45° FOV, 848 x 848 pixels.
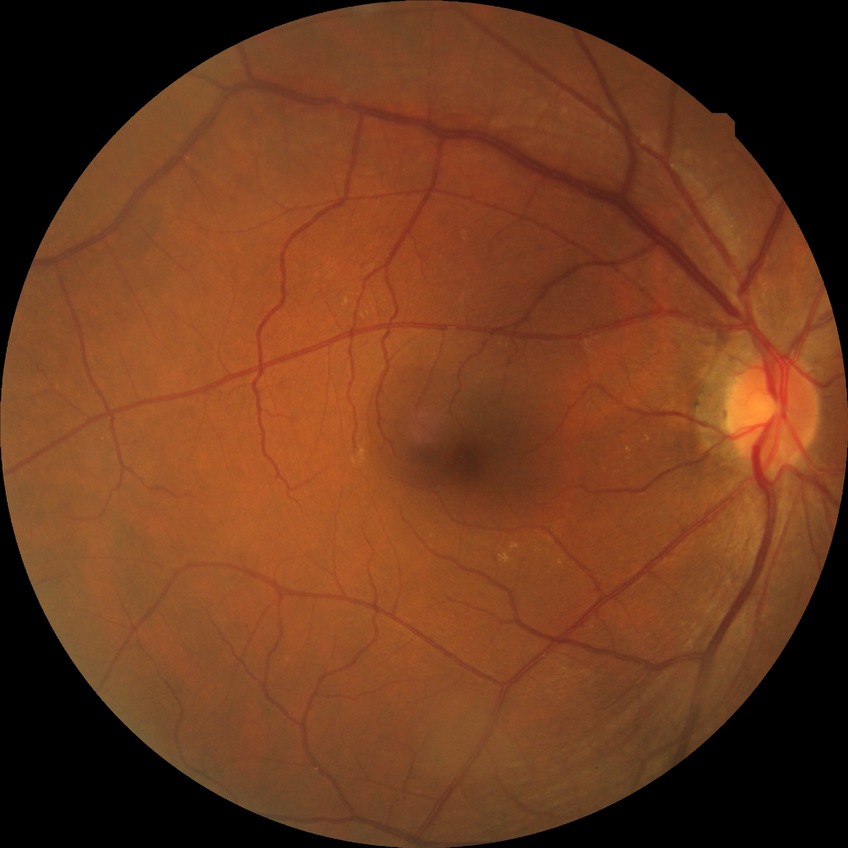
davis_grade: no diabetic retinopathy (NDR)